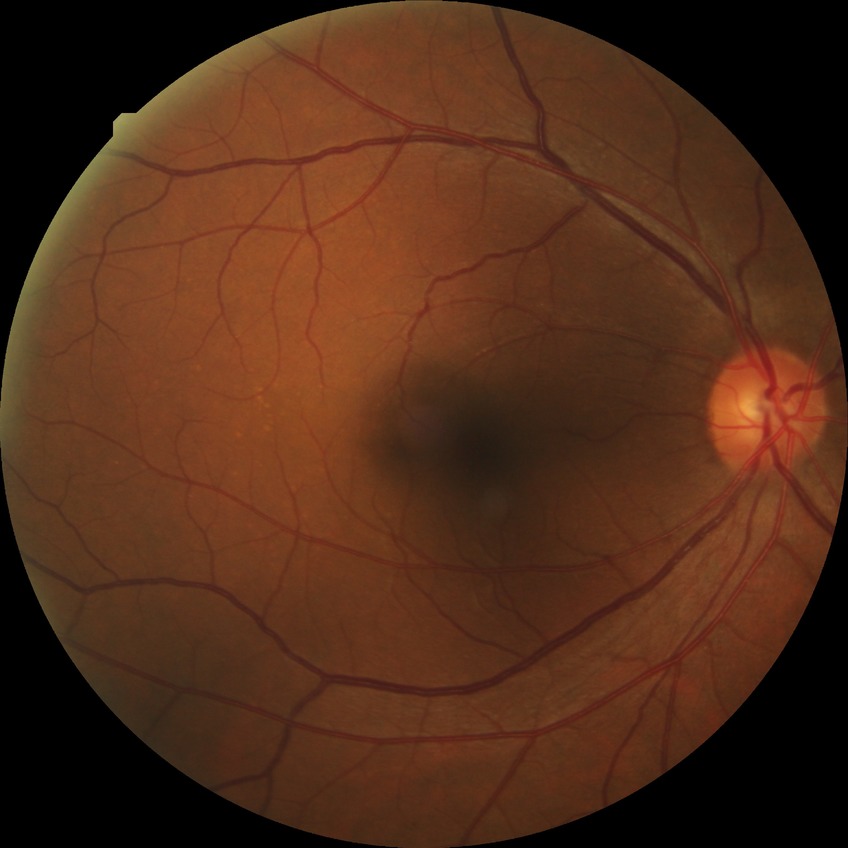
modified Davis grading=simple diabetic retinopathy.